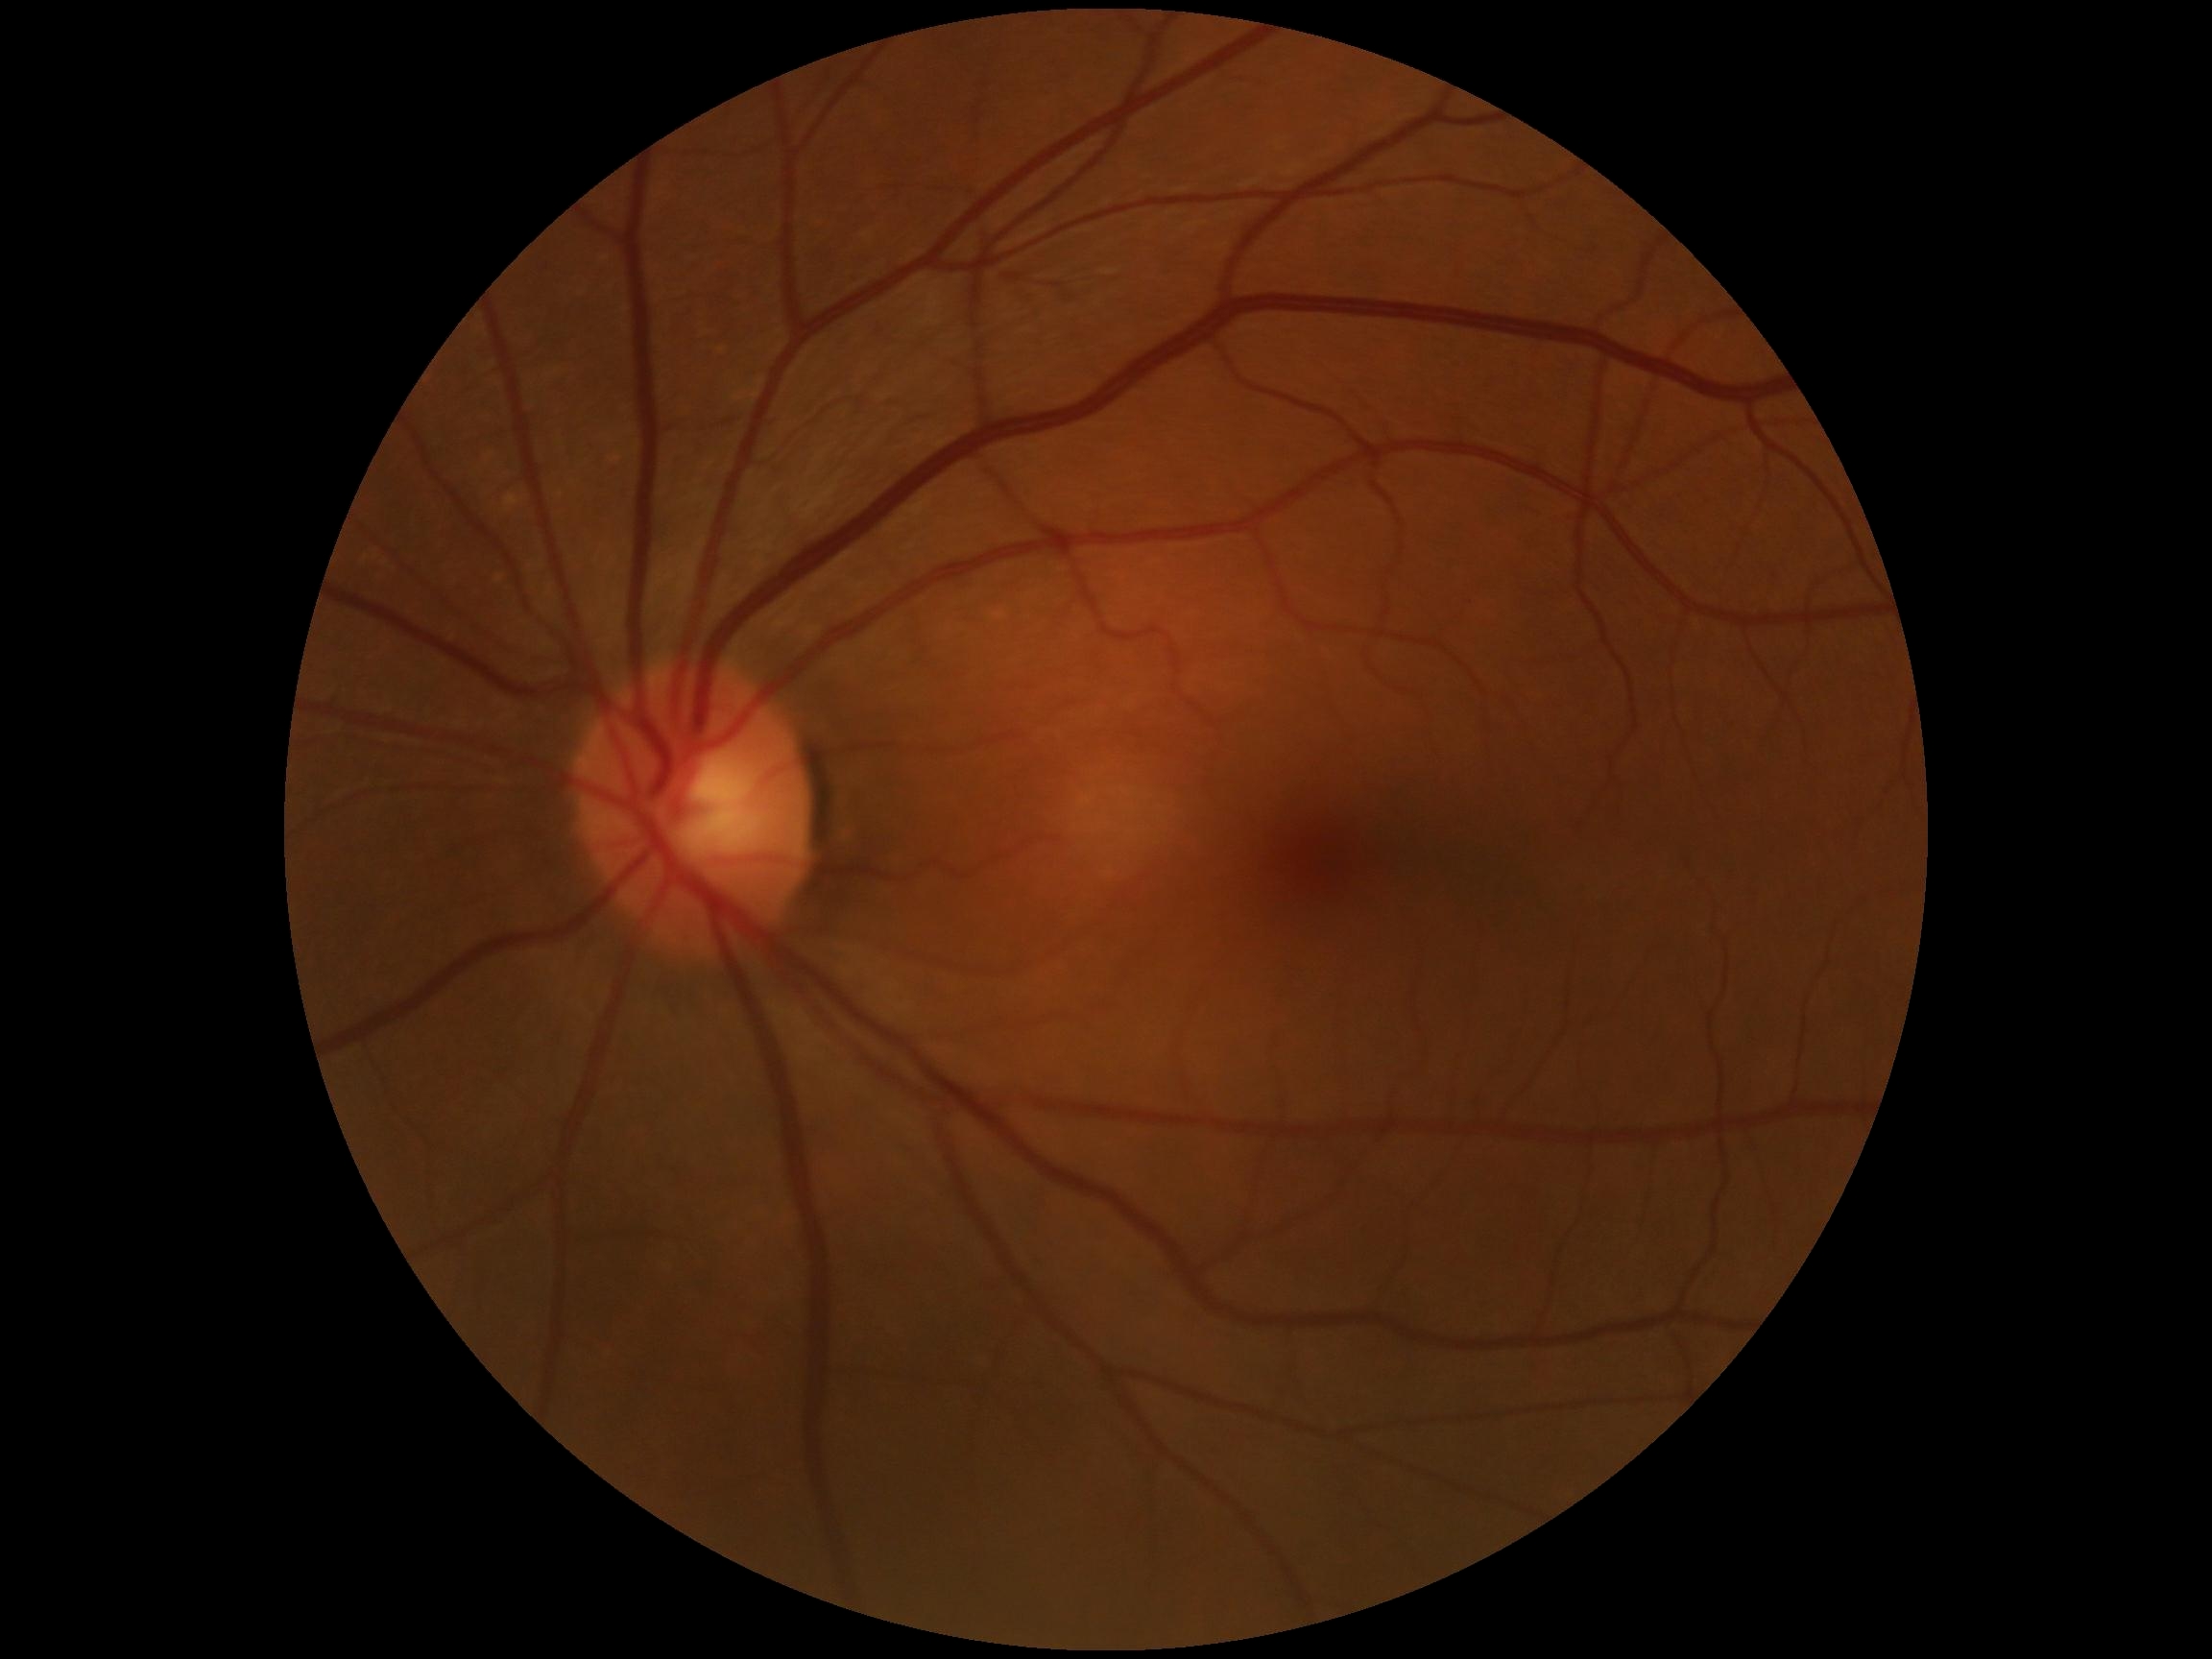

DR stage: grade 0 (no apparent retinopathy).